Infant wide-field retinal image; image size 1240x1240:
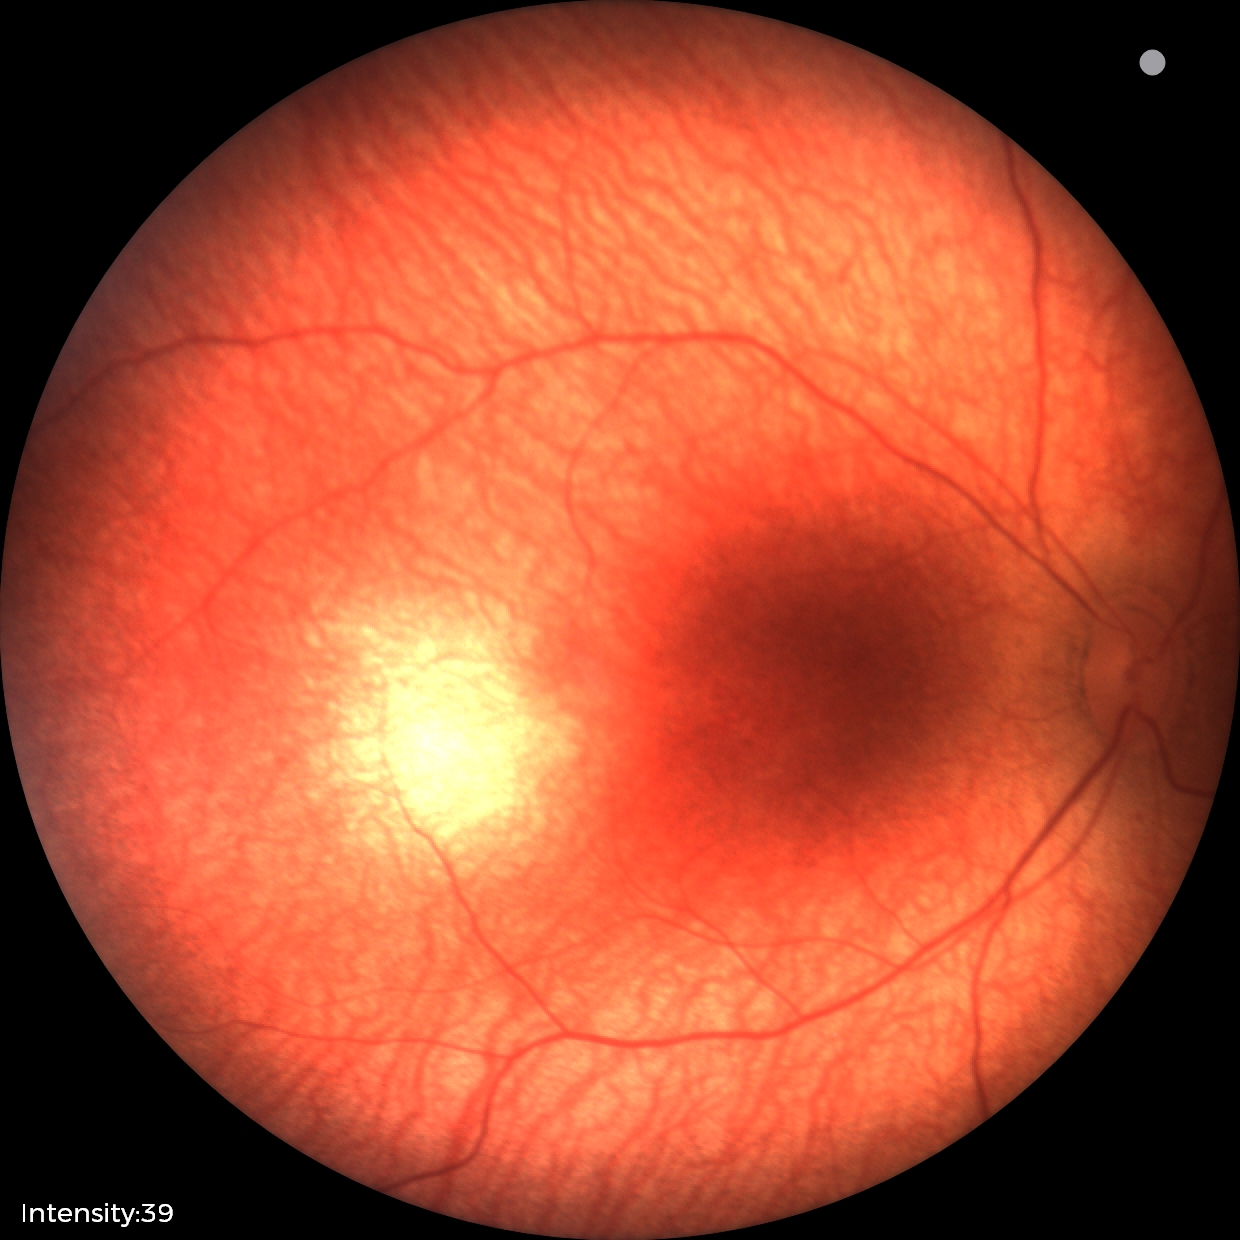 Screening examination with no abnormal retinal findings.